Phoenix ICON wide-field infant fundus image: 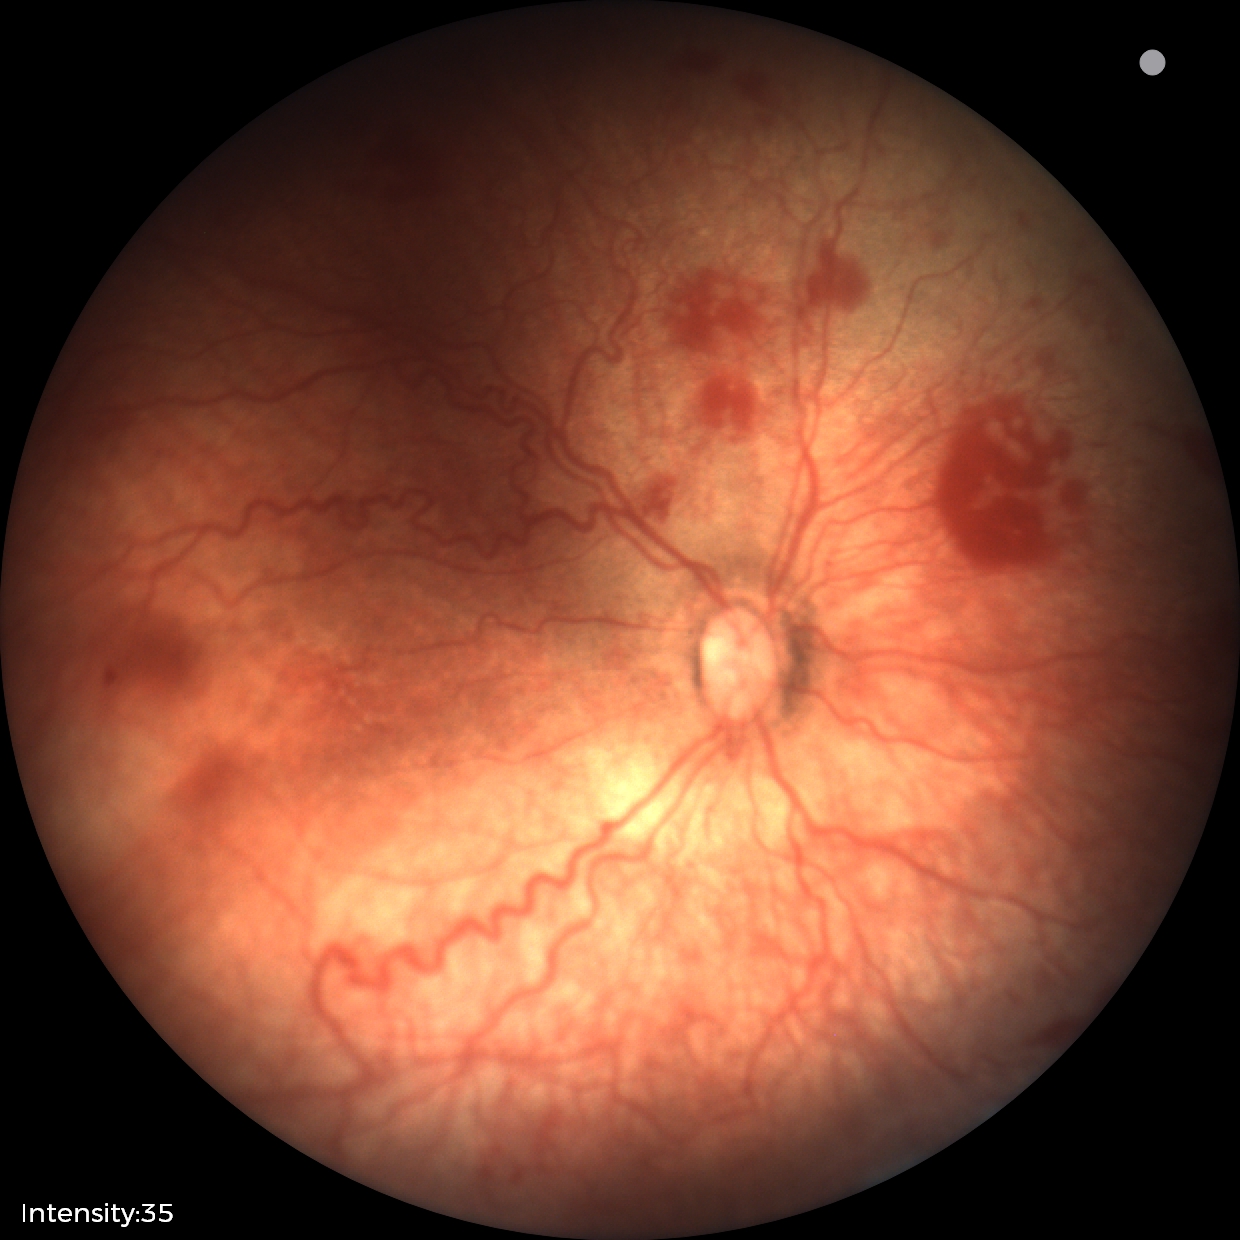
Diagnosis from this screening exam: ROP stage 2. Plus disease was diagnosed.